Image size 2352x1568, 45° FOV:
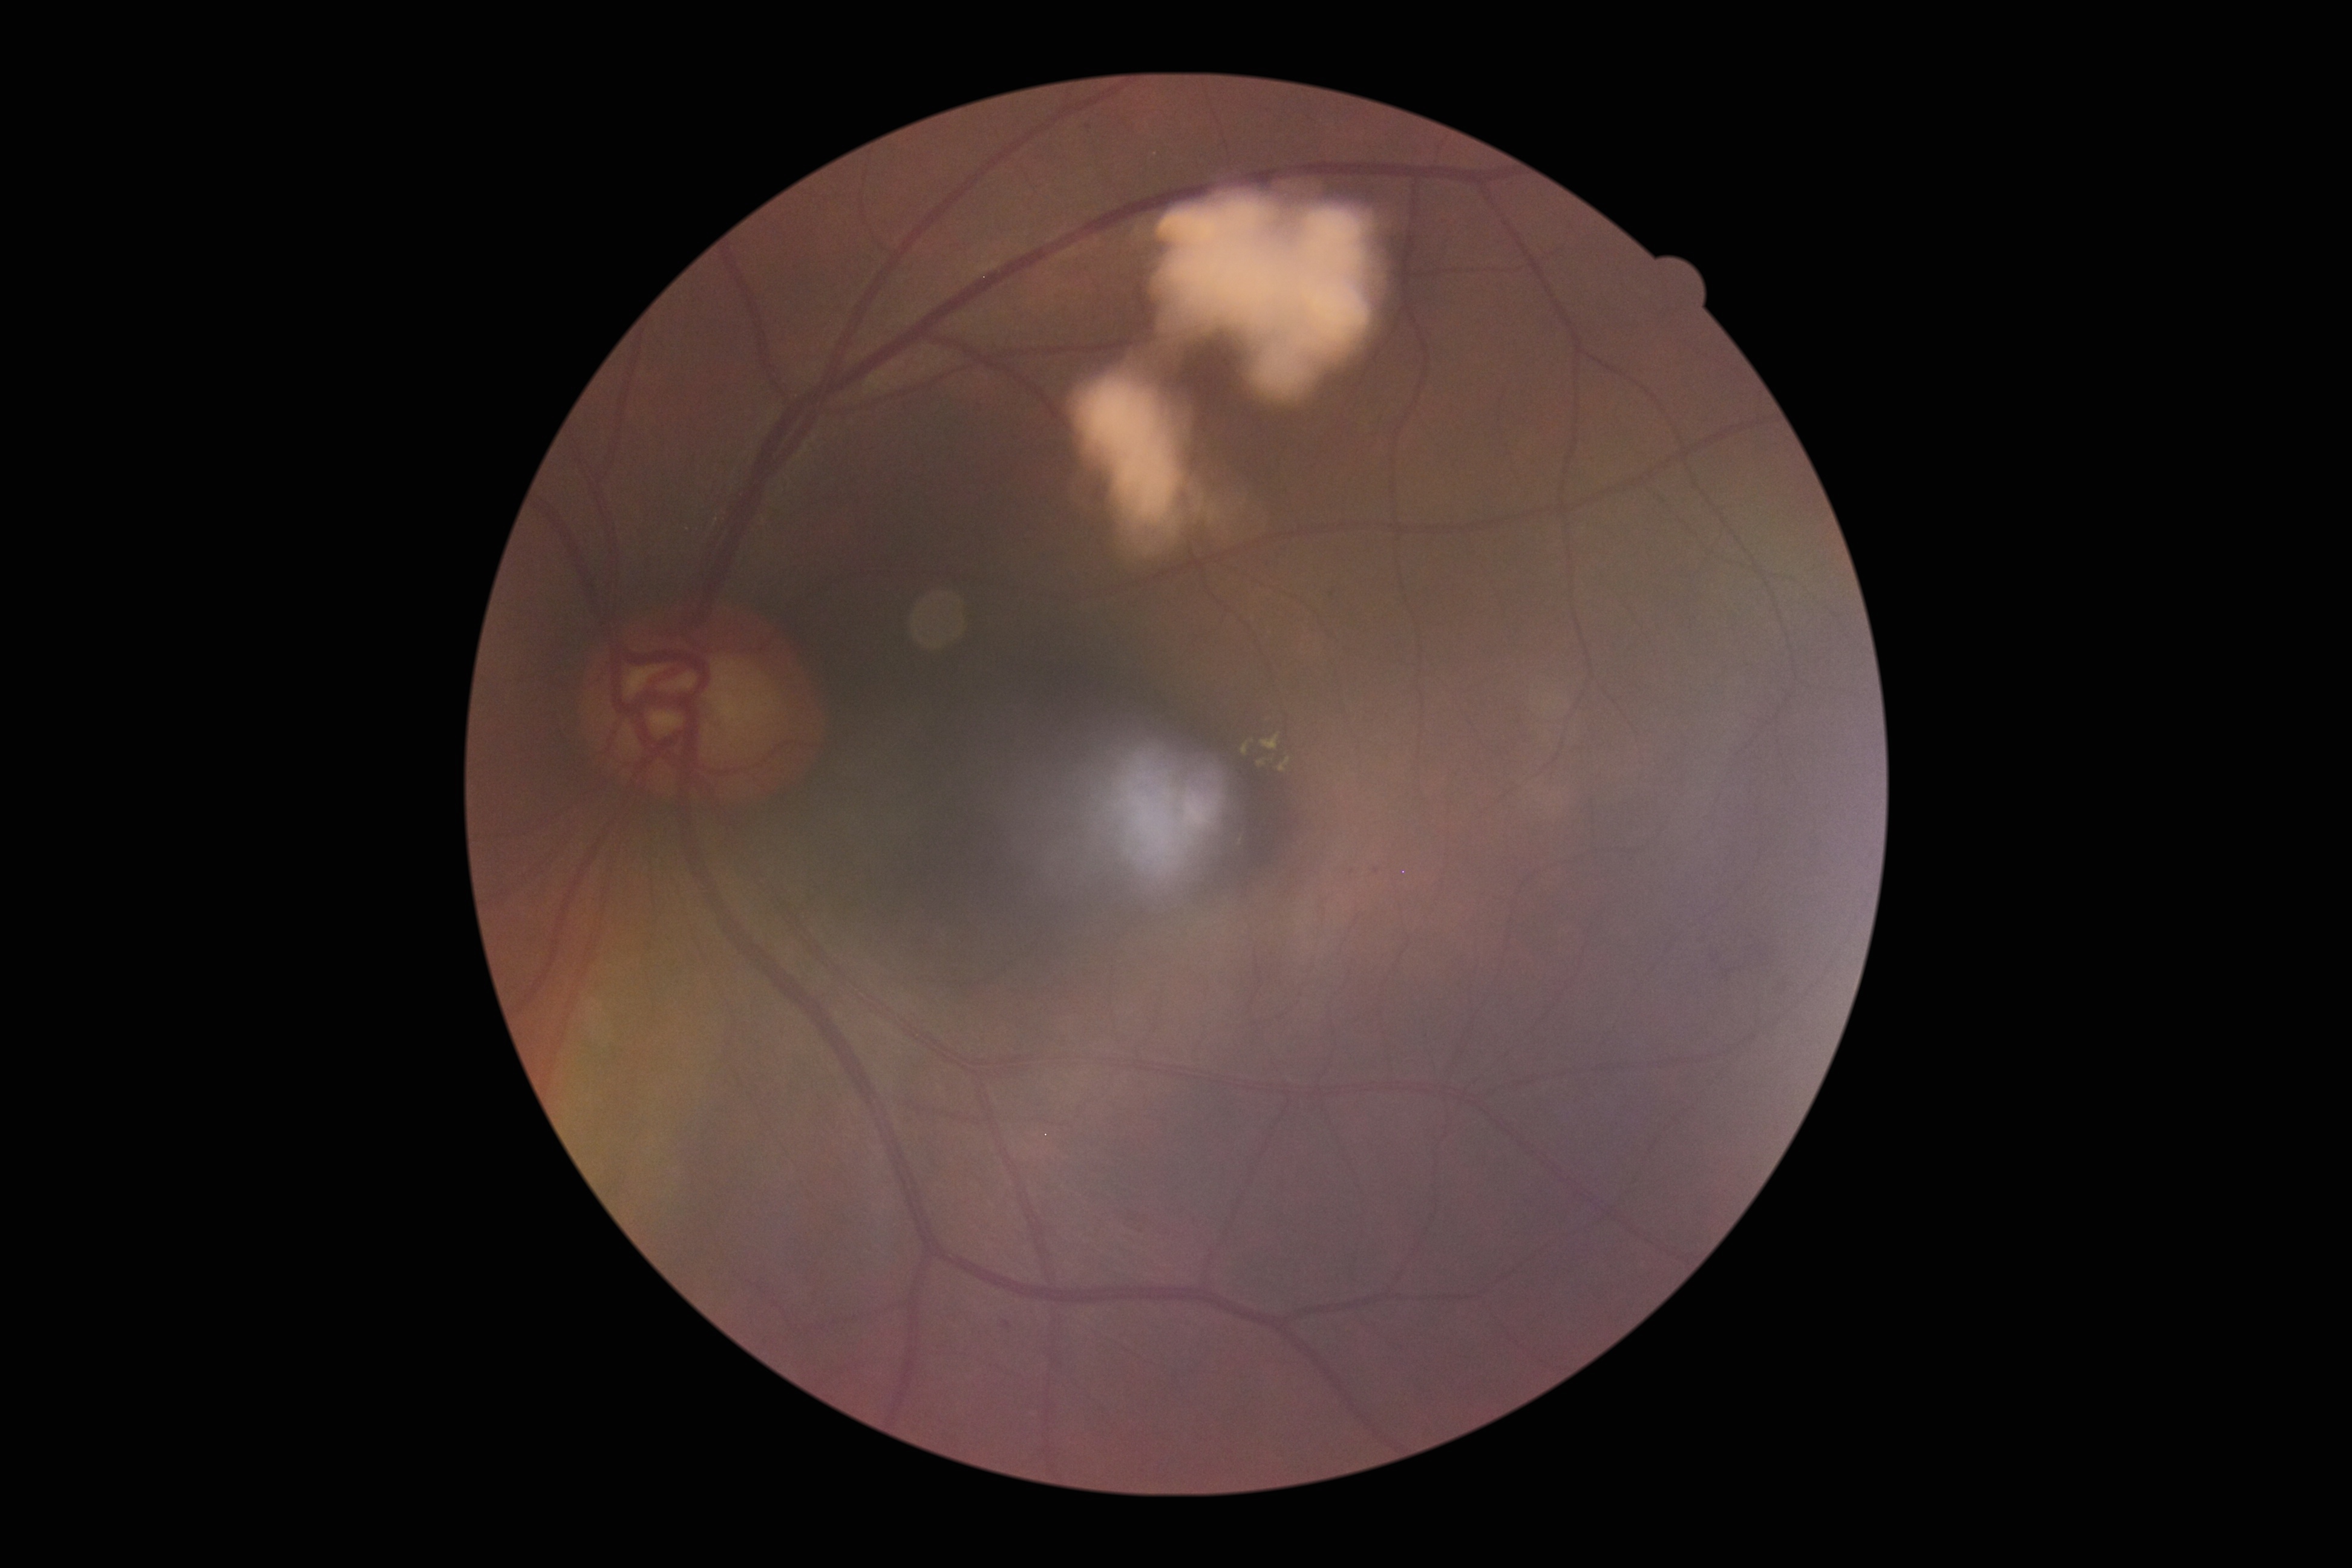

Diabetic retinopathy (DR) is moderate non-proliferative diabetic retinopathy (grade 2).